45-degree field of view, color fundus image.
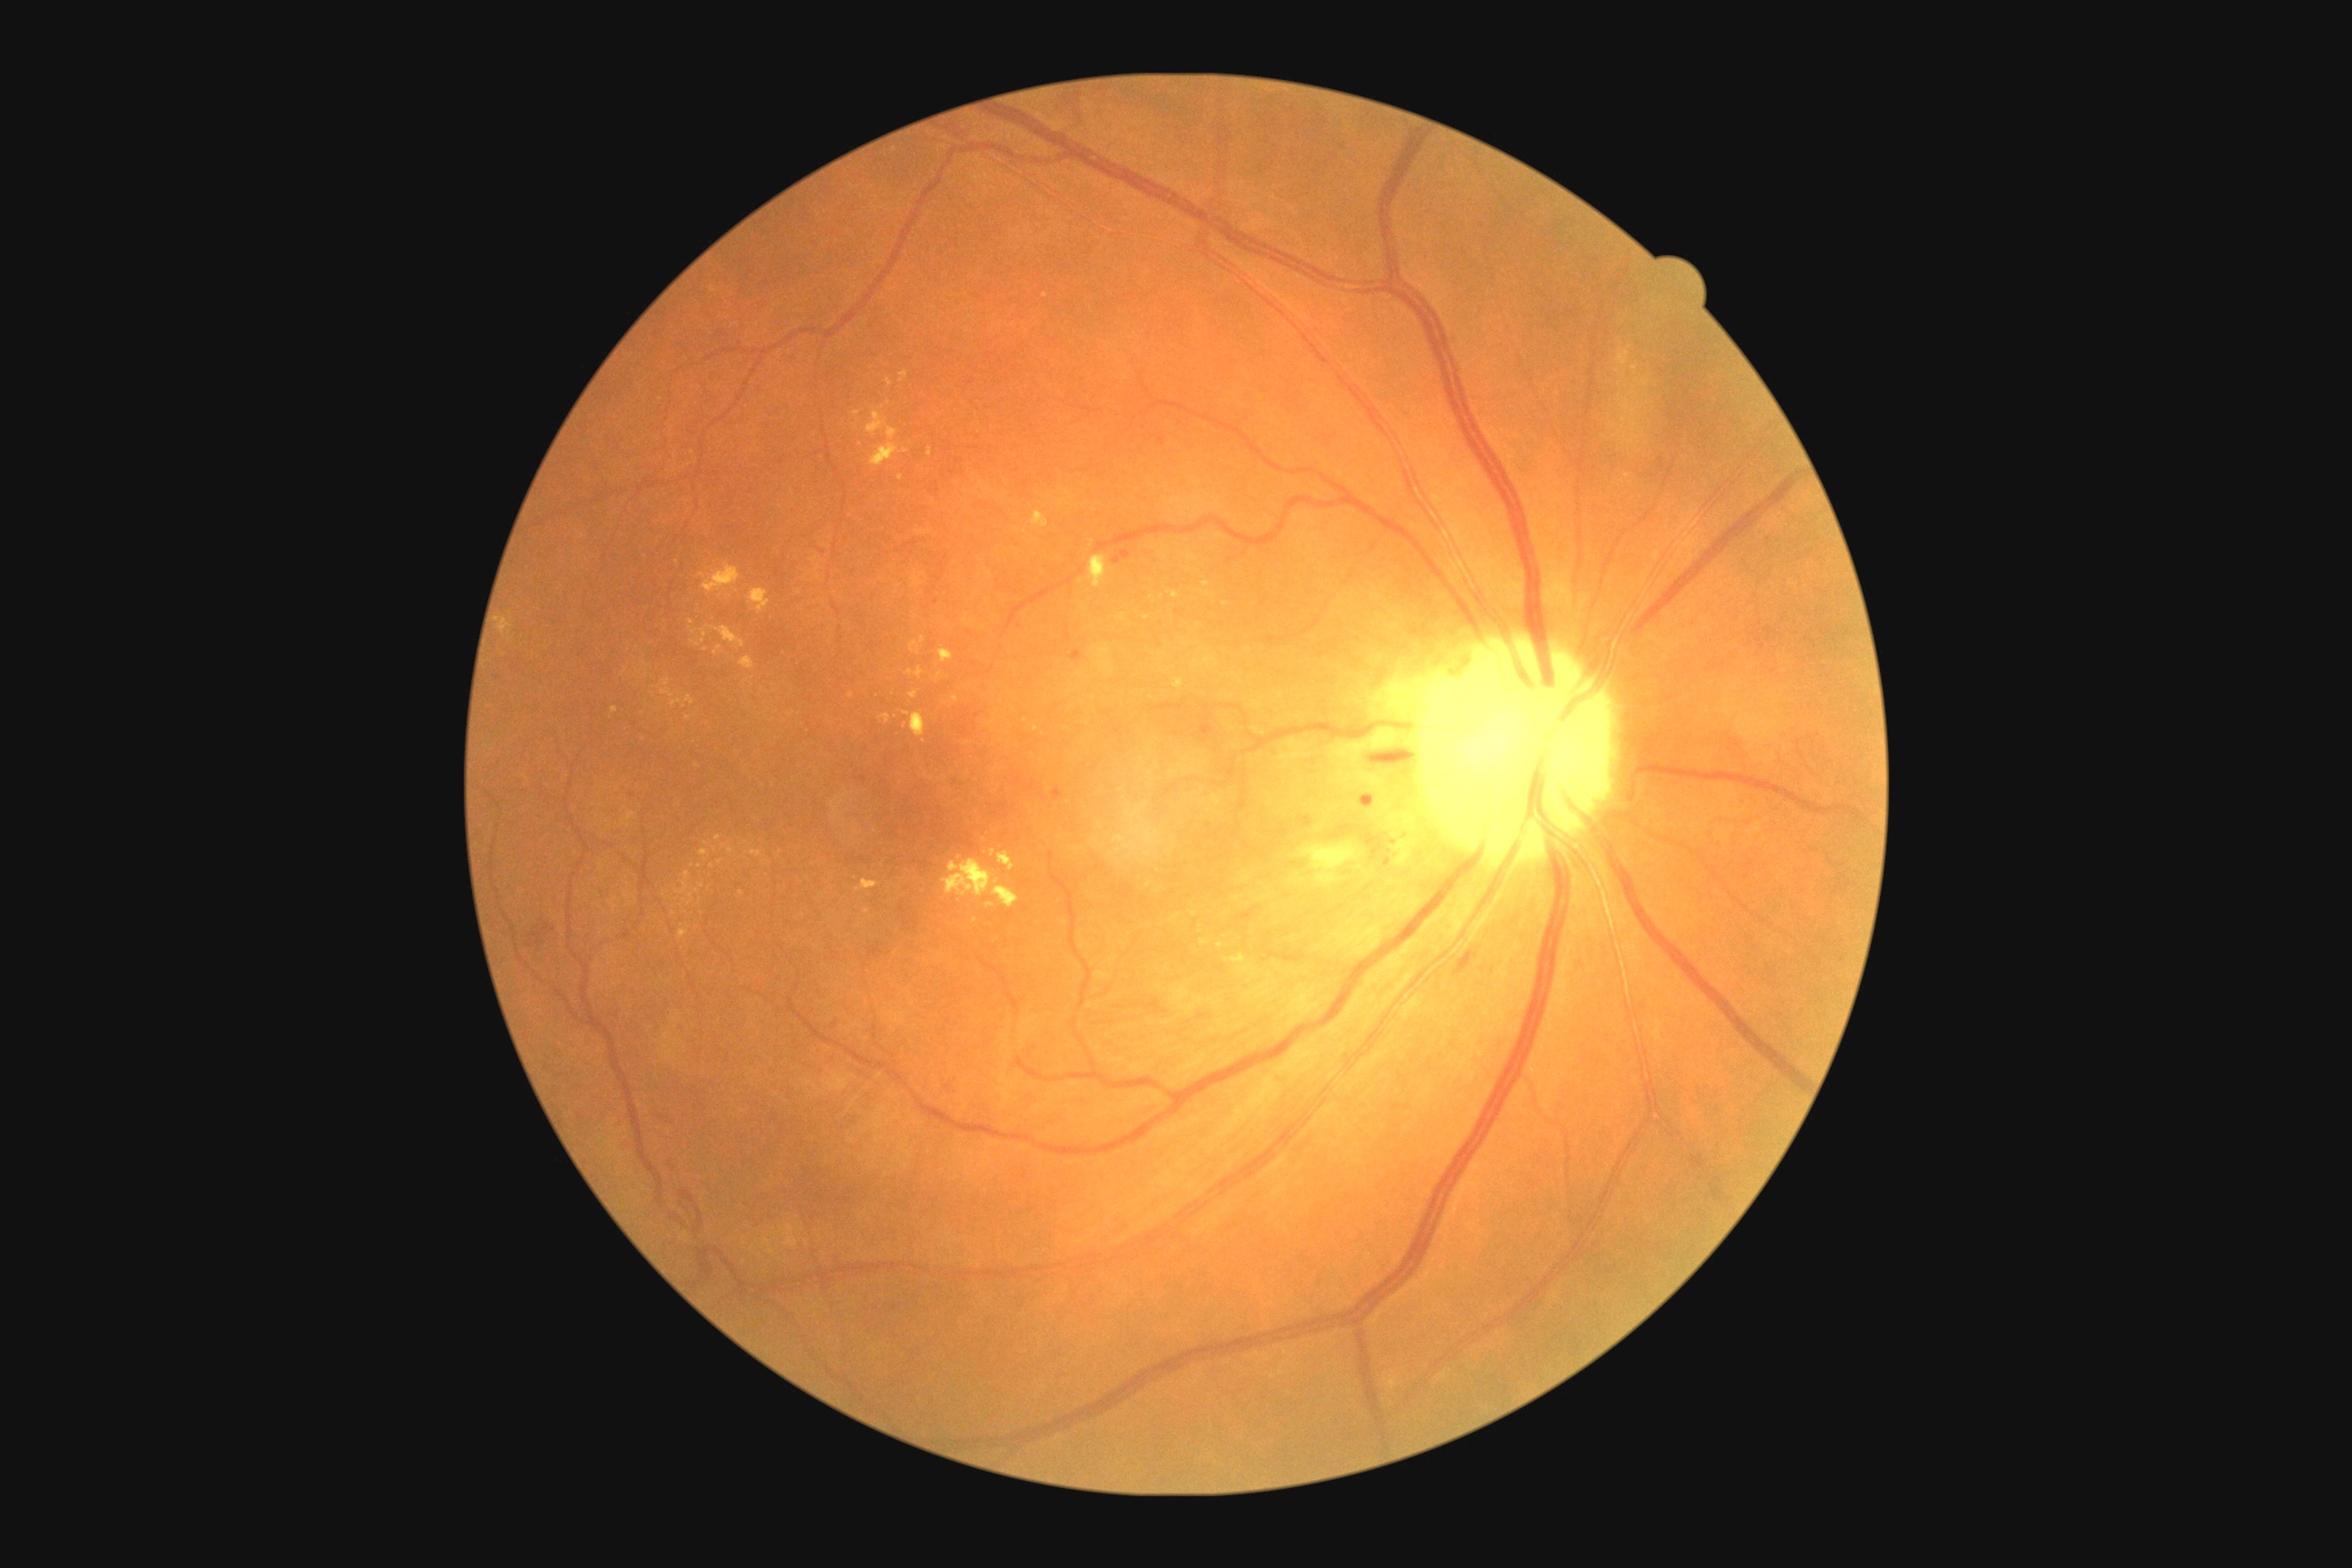
{"partial": true, "dr_grade": 2, "dr_grade_name": "moderate NPDR", "lesions": {"ex": [[921, 636, 926, 645], [926, 447, 932, 458], [710, 627, 745, 649], [1170, 591, 1181, 600], [1200, 939, 1208, 945], [672, 700, 683, 709], [1112, 834, 1126, 843], [887, 378, 894, 387], [1032, 511, 1050, 529], [498, 618, 511, 632]], "ex_small_centers": [[1209, 594], [688, 875], [1226, 605], [900, 479], [961, 858], [975, 921], [1147, 619], [699, 866], [652, 694]]}}